NIDEK AFC-230; 848 by 848 pixels: 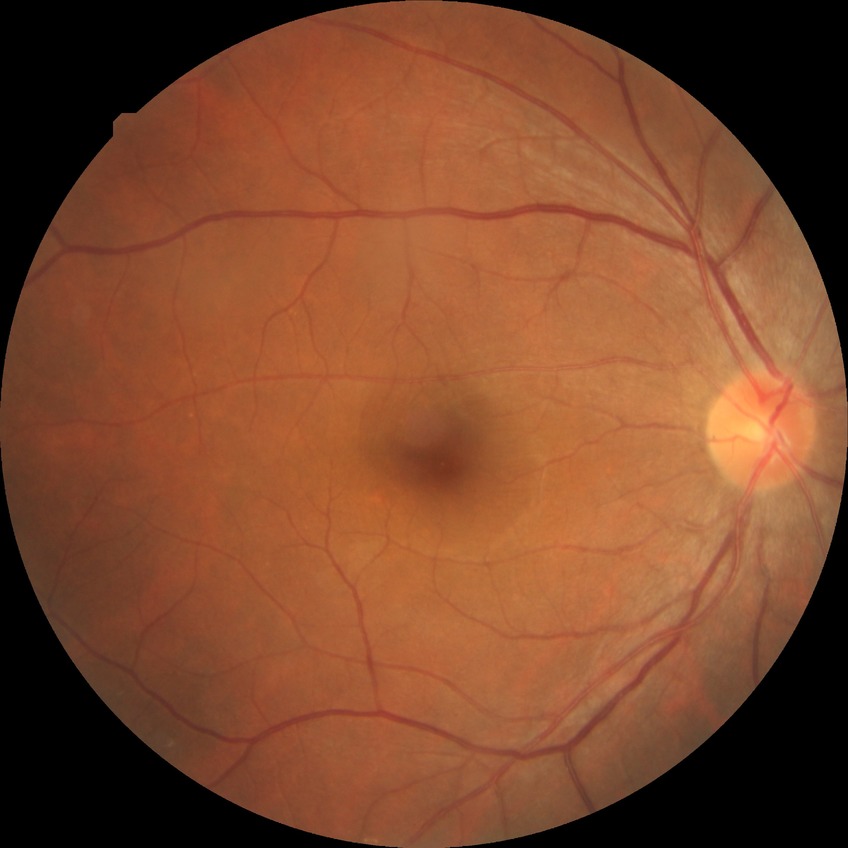

Findings:
* retinopathy stage: simple diabetic retinopathy